Cropped to the optic nerve head.
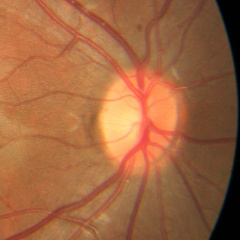 Optic nerve head appearance consistent with no glaucomatous optic neuropathy.